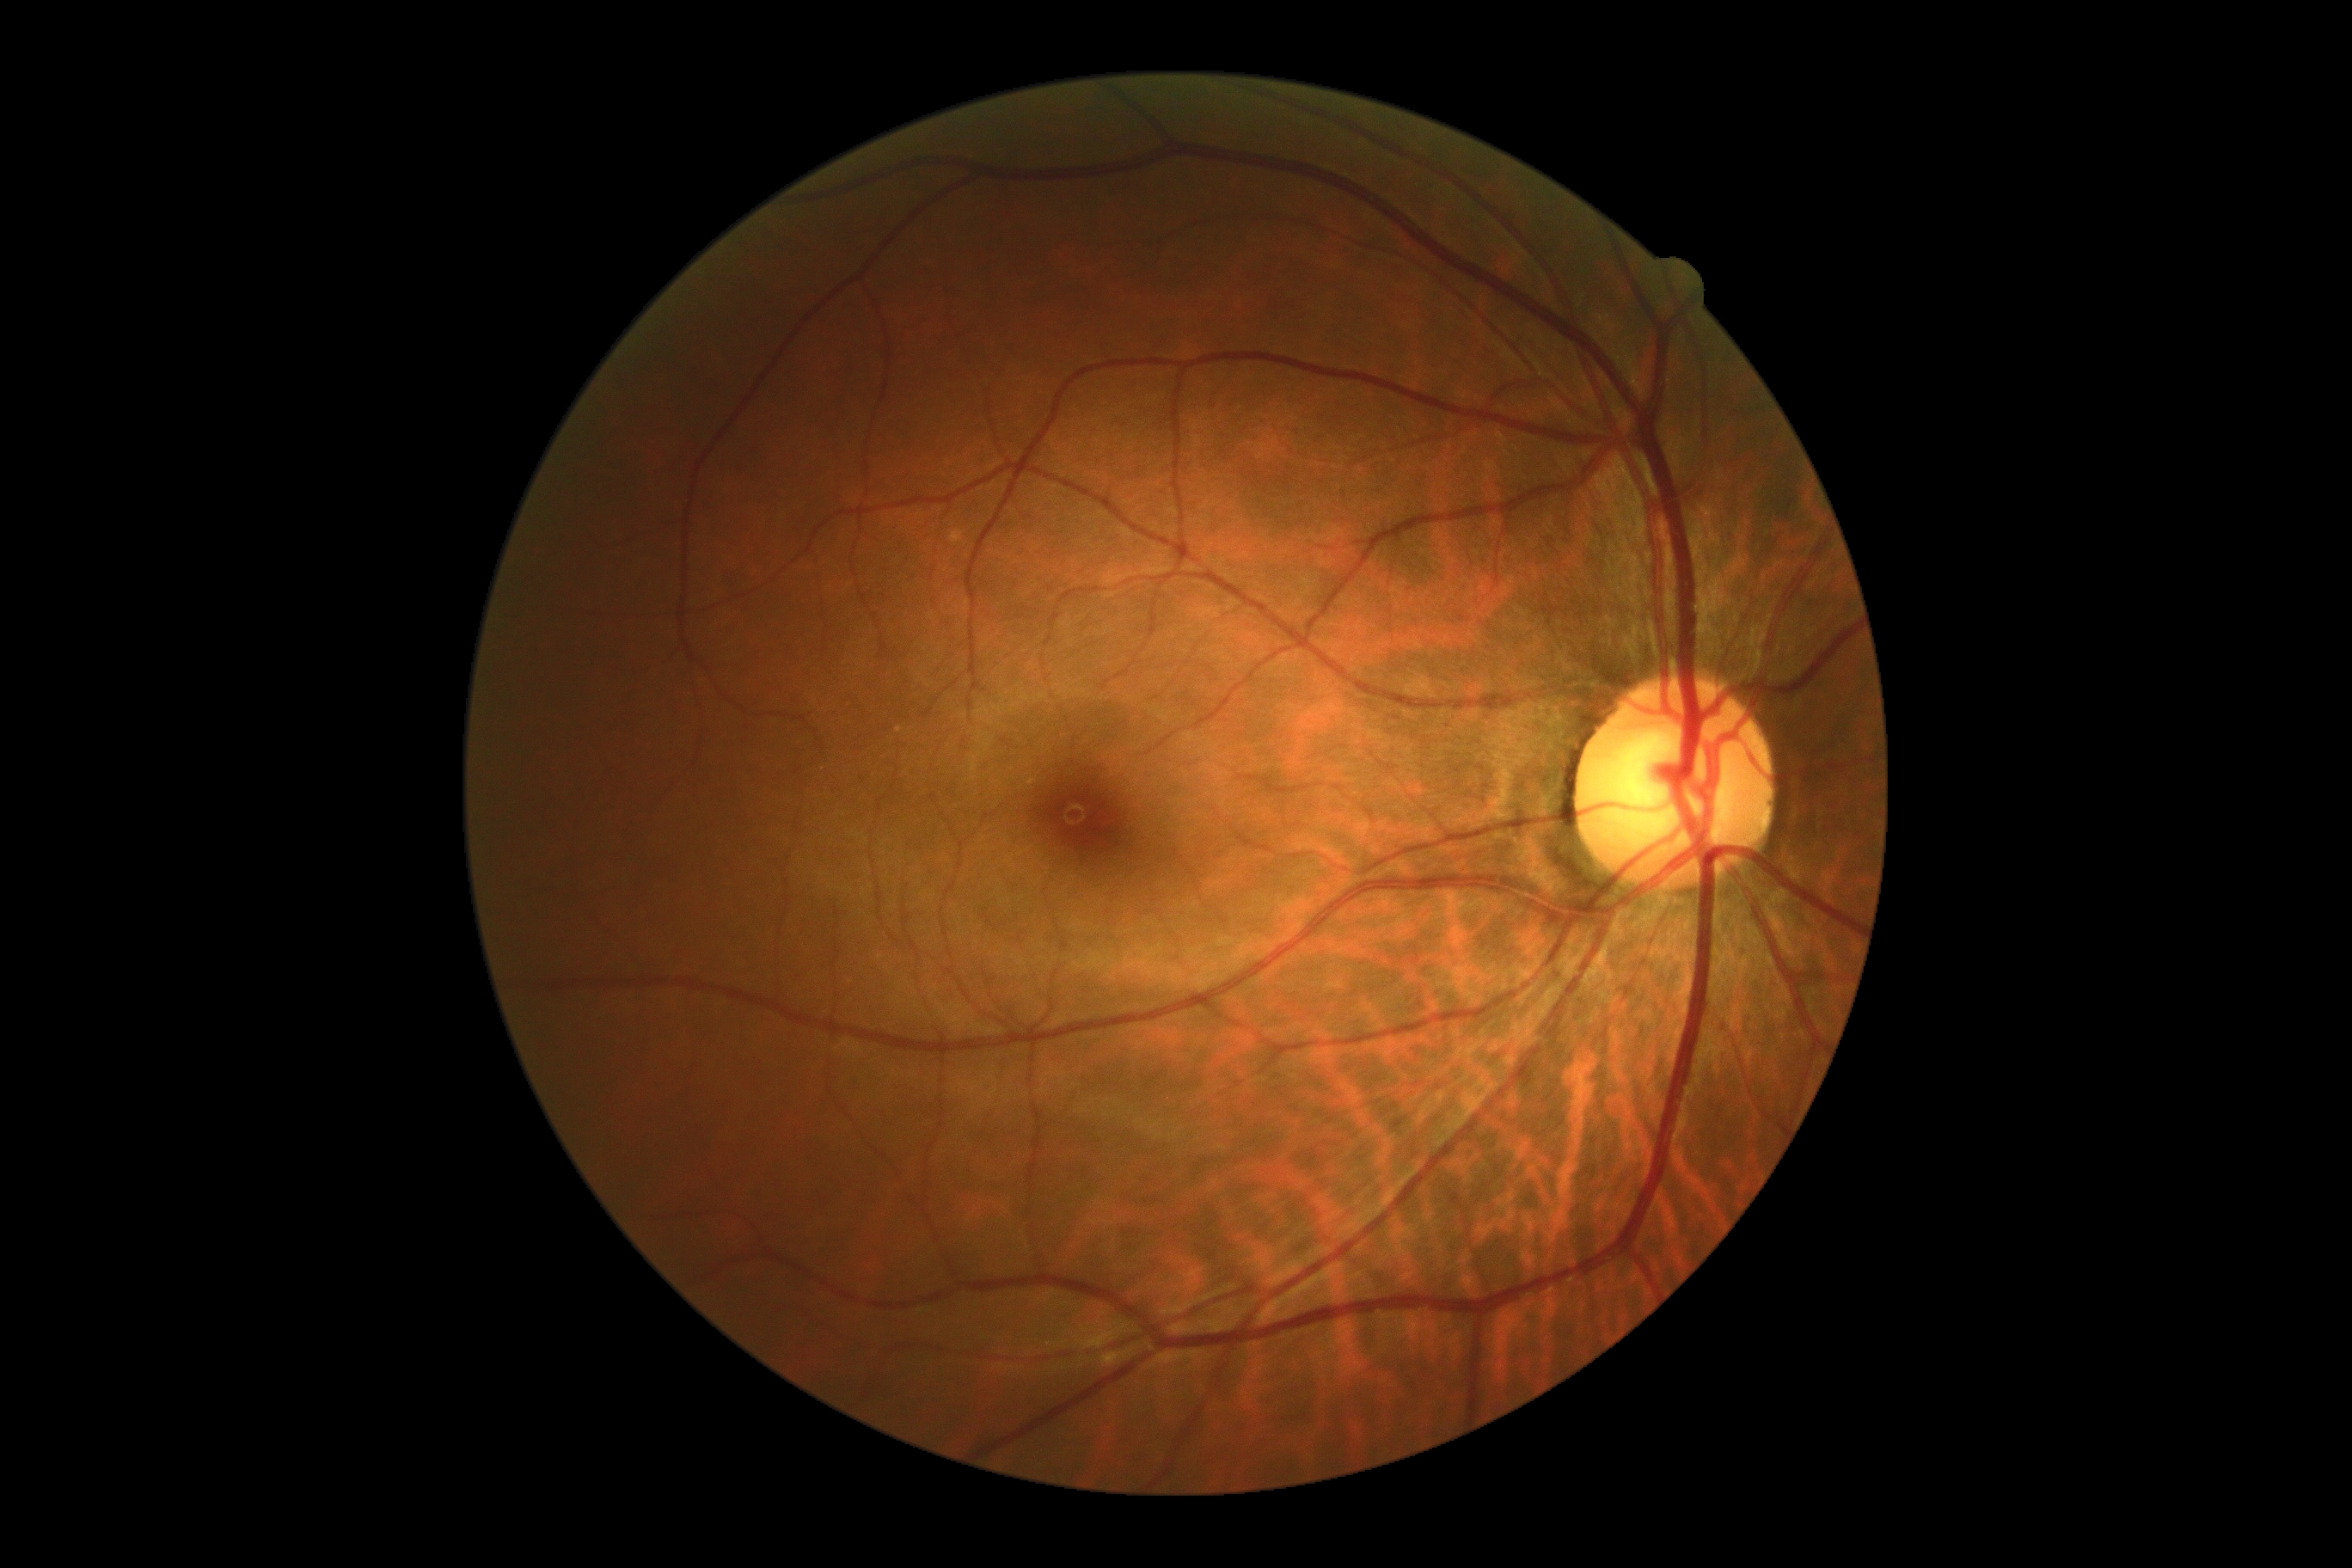
dr_grade: no apparent retinopathy (0)